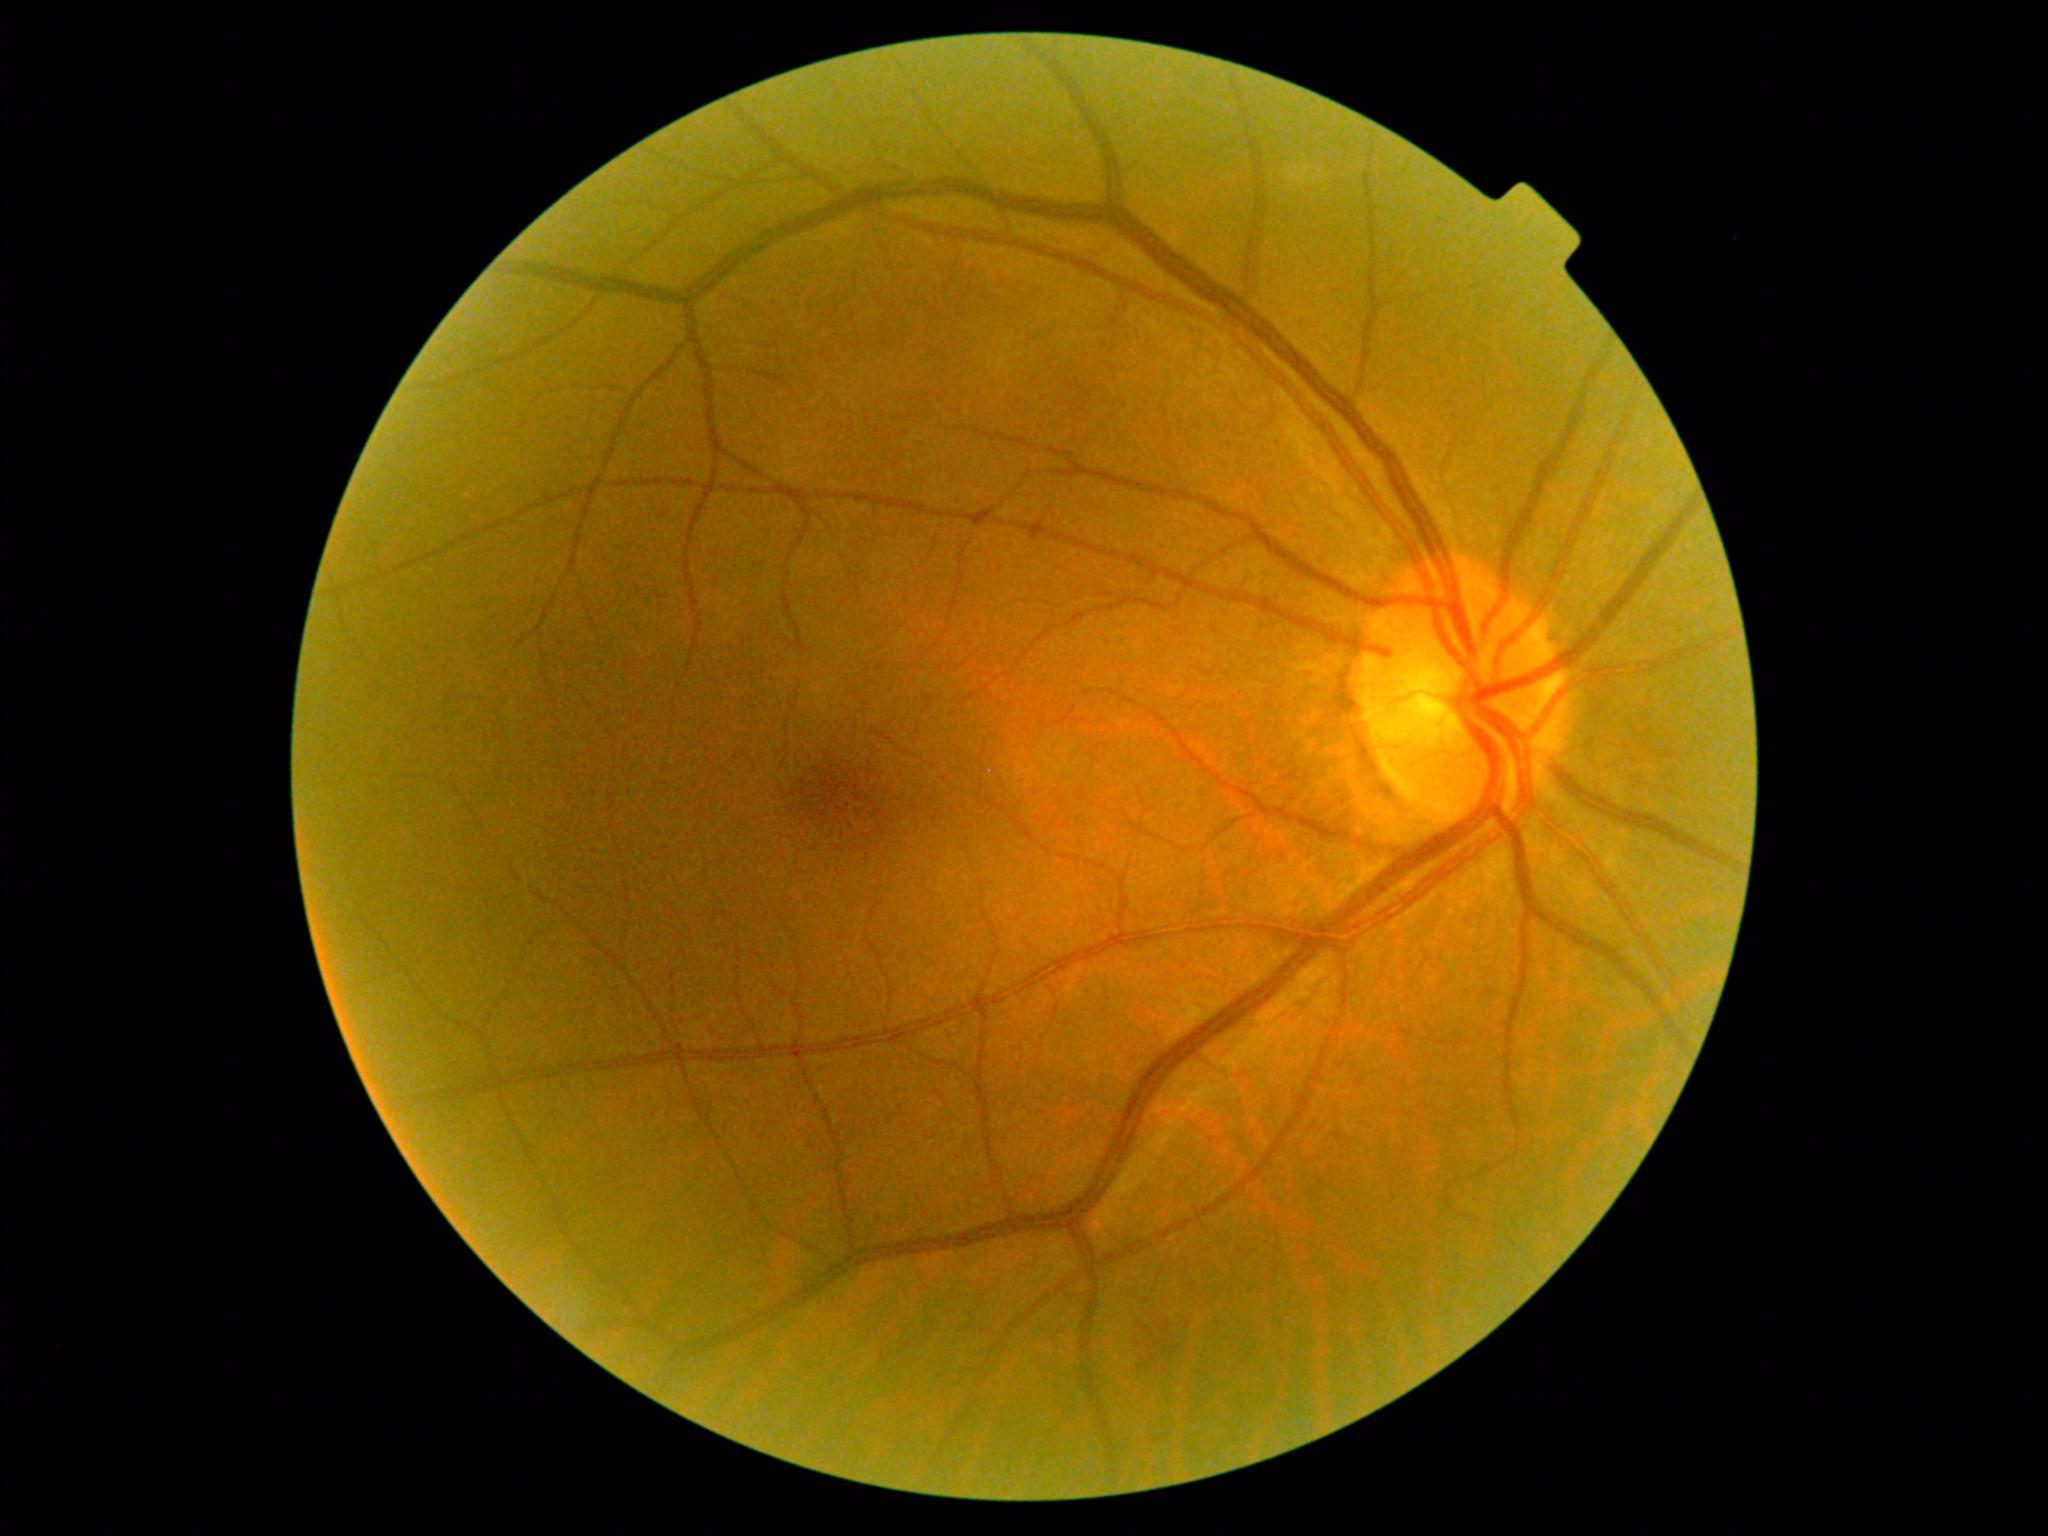

DR class: non-proliferative diabetic retinopathy.
DR: moderate non-proliferative diabetic retinopathy (grade 2).